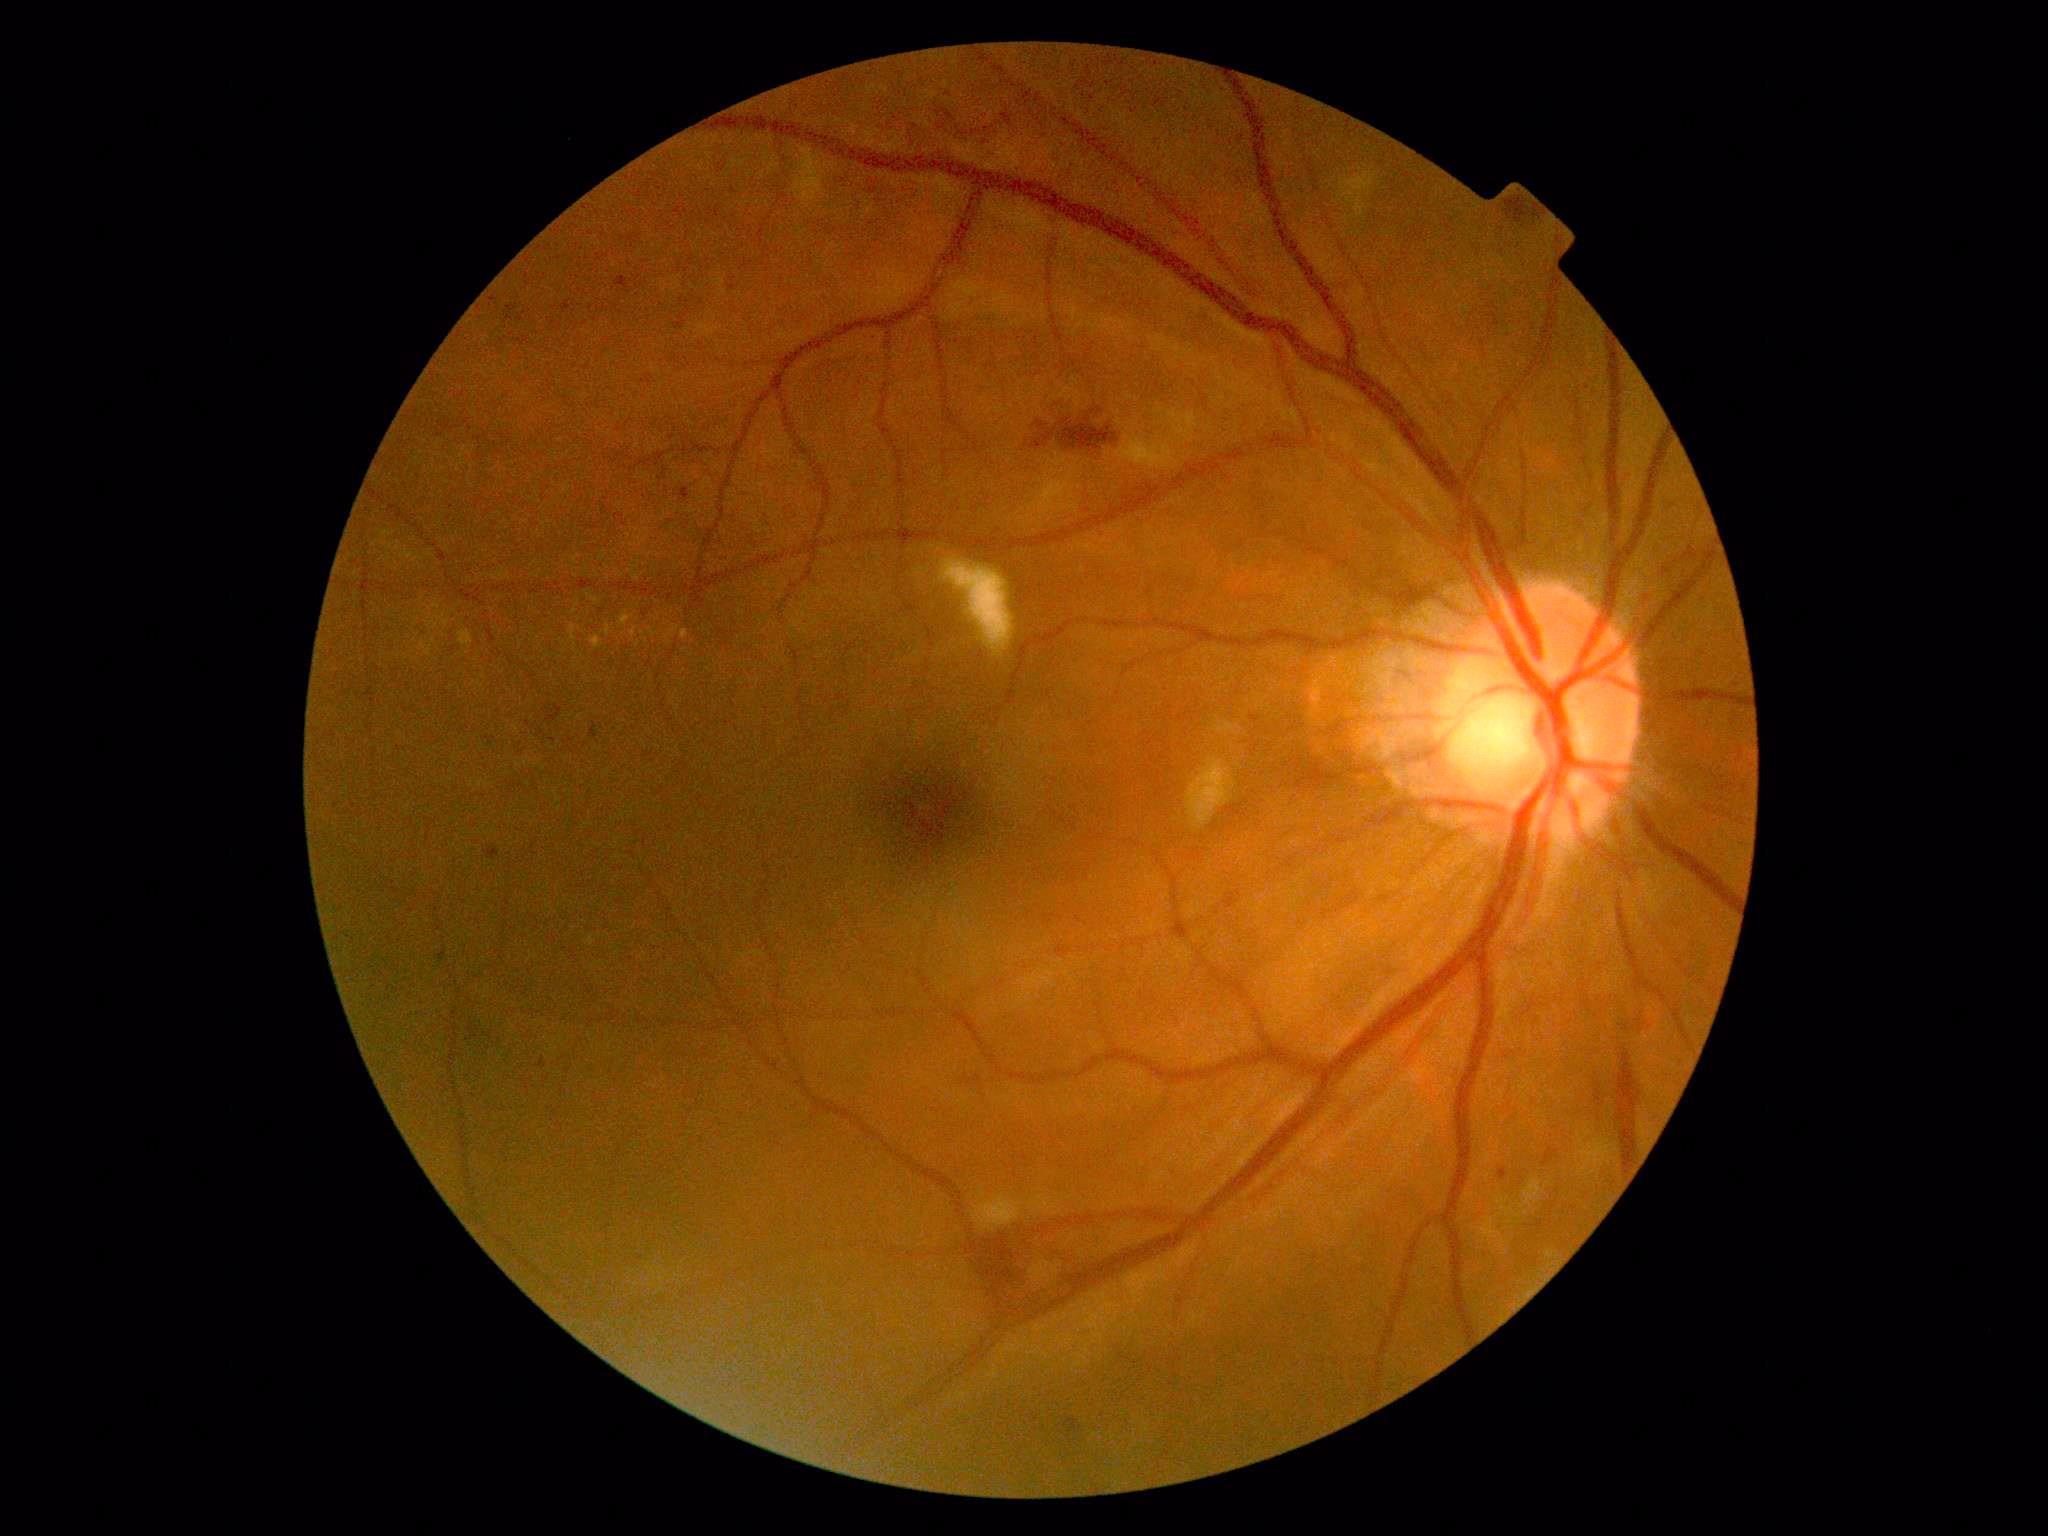
diabetic retinopathy severity@moderate non-proliferative diabetic retinopathy (grade 2).